2352 by 1568 pixels · 45-degree field of view:
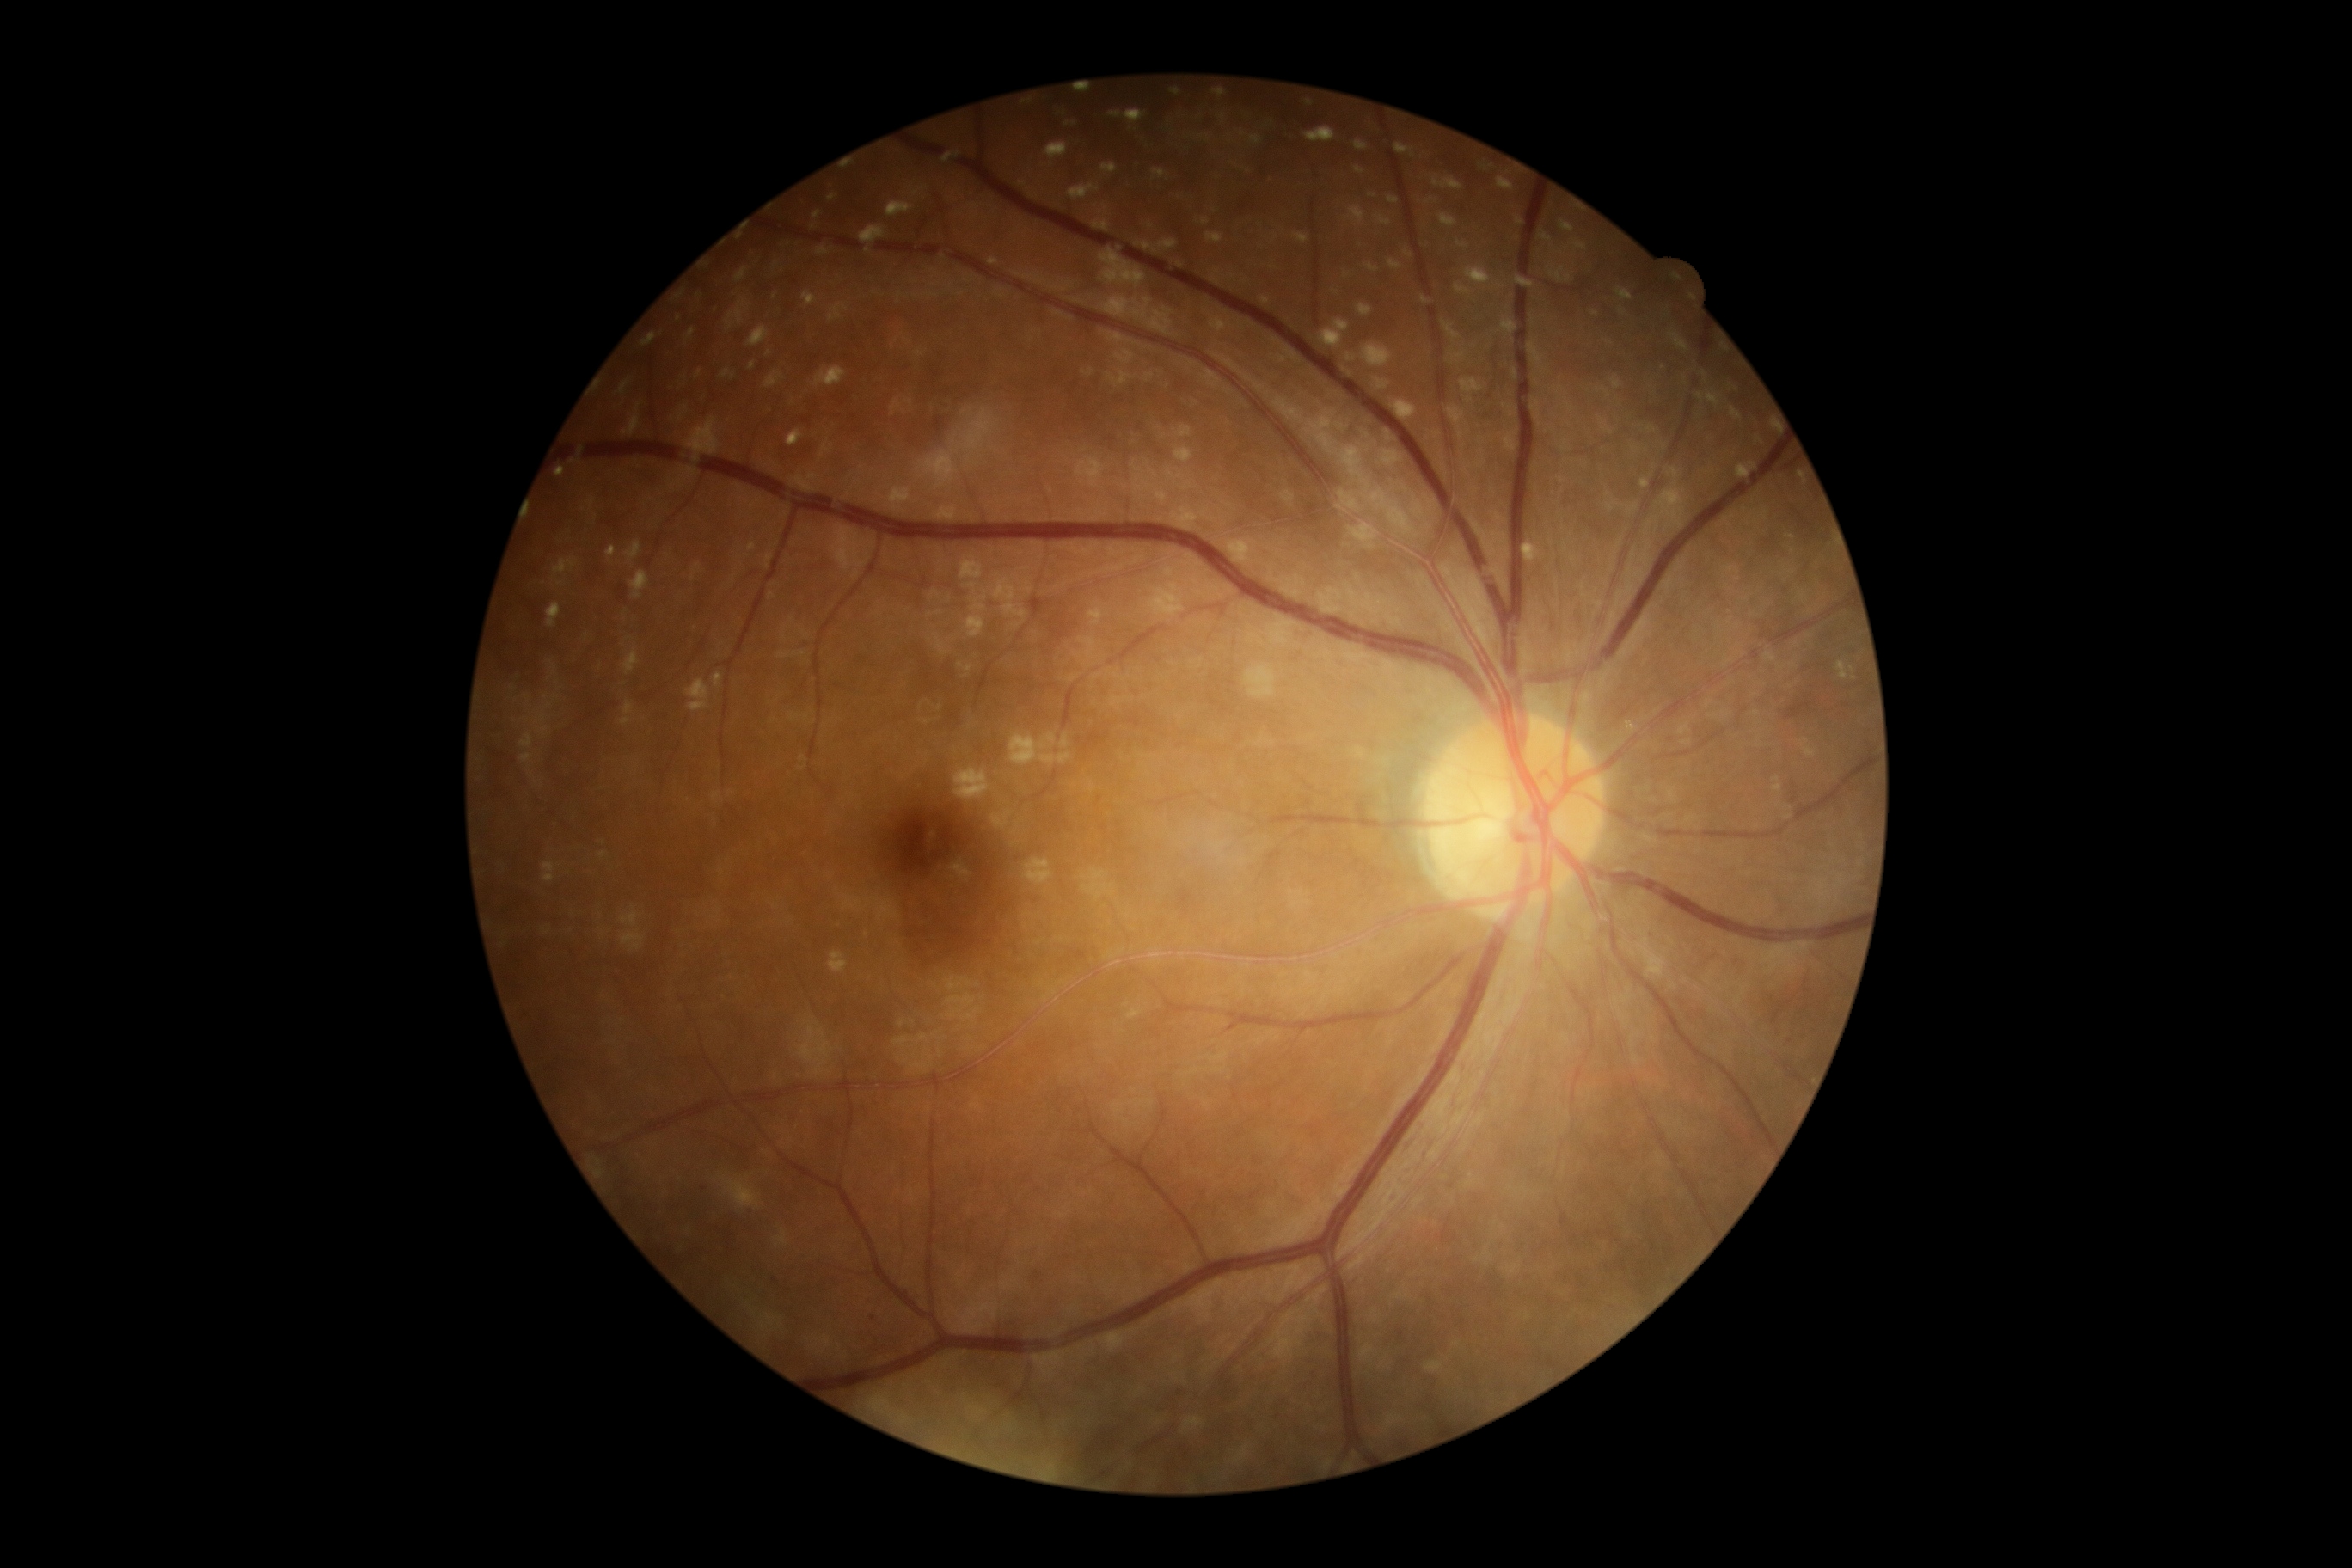 dr_category: non-proliferative diabetic retinopathy
dr_grade: mild NPDR (grade 1)